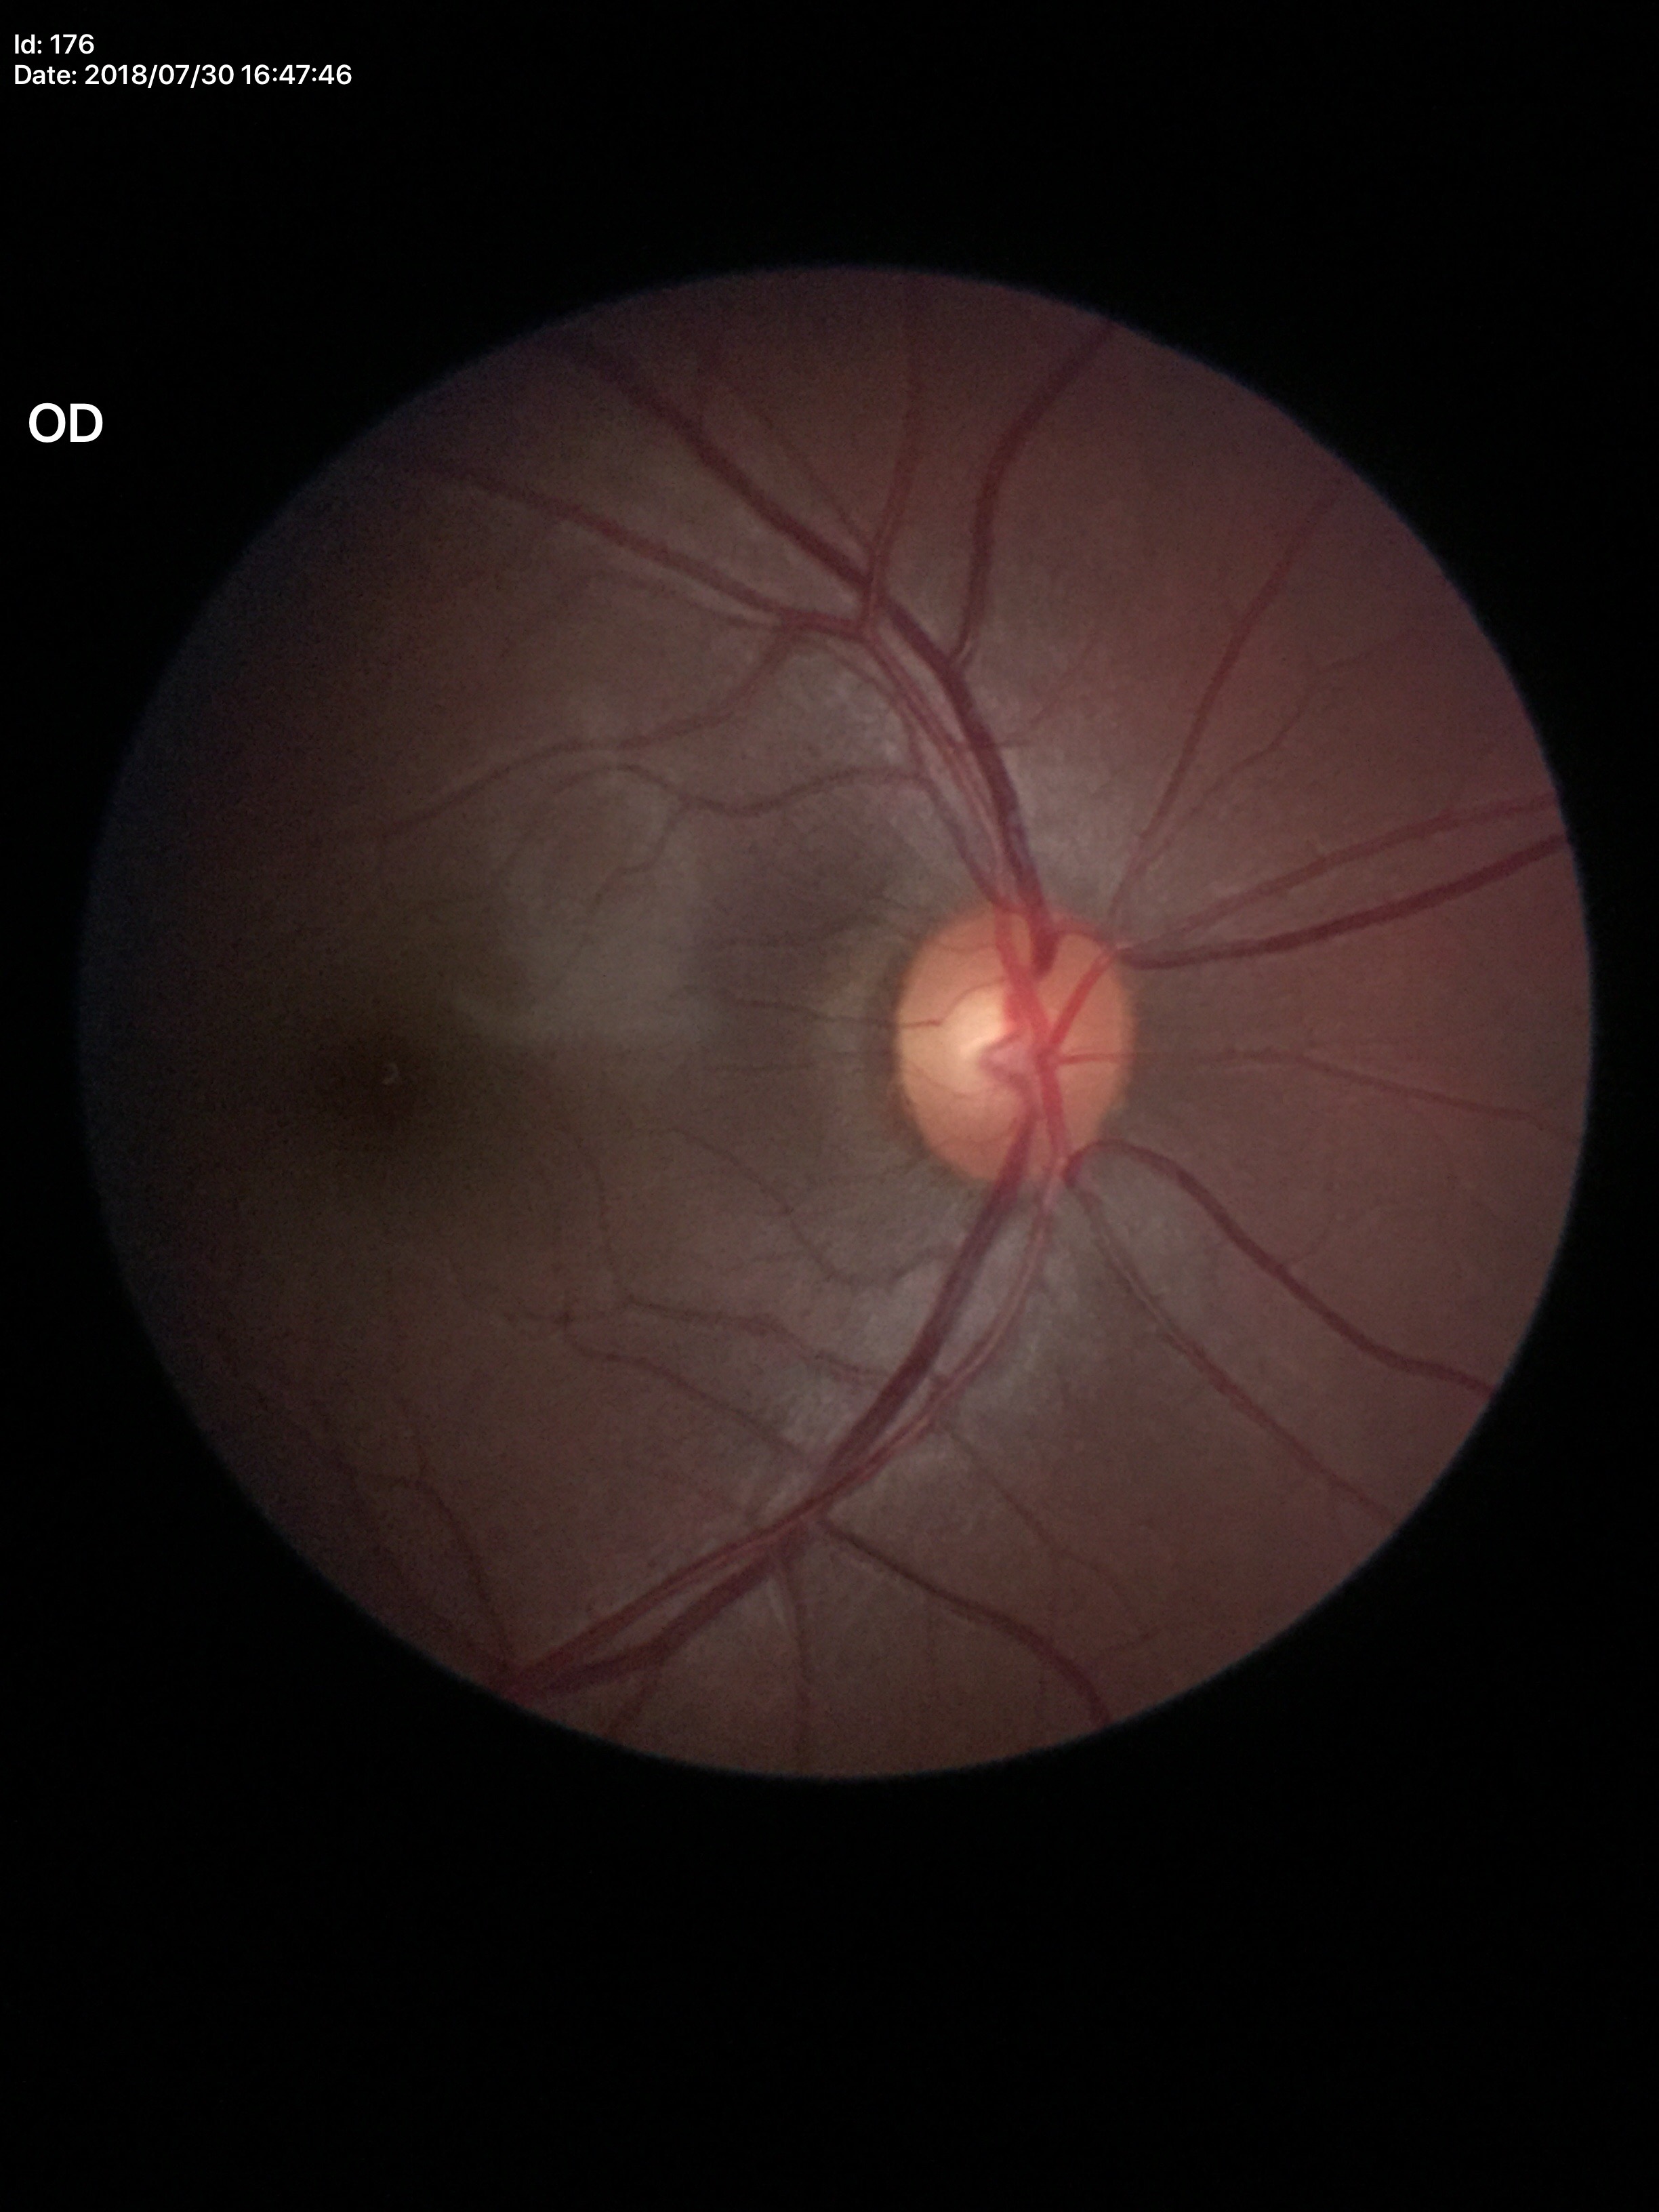
Not suspicious for glaucoma.
VCDR is 0.54.